1440 x 1080 pixels; pediatric retinal photograph (wide-field) — 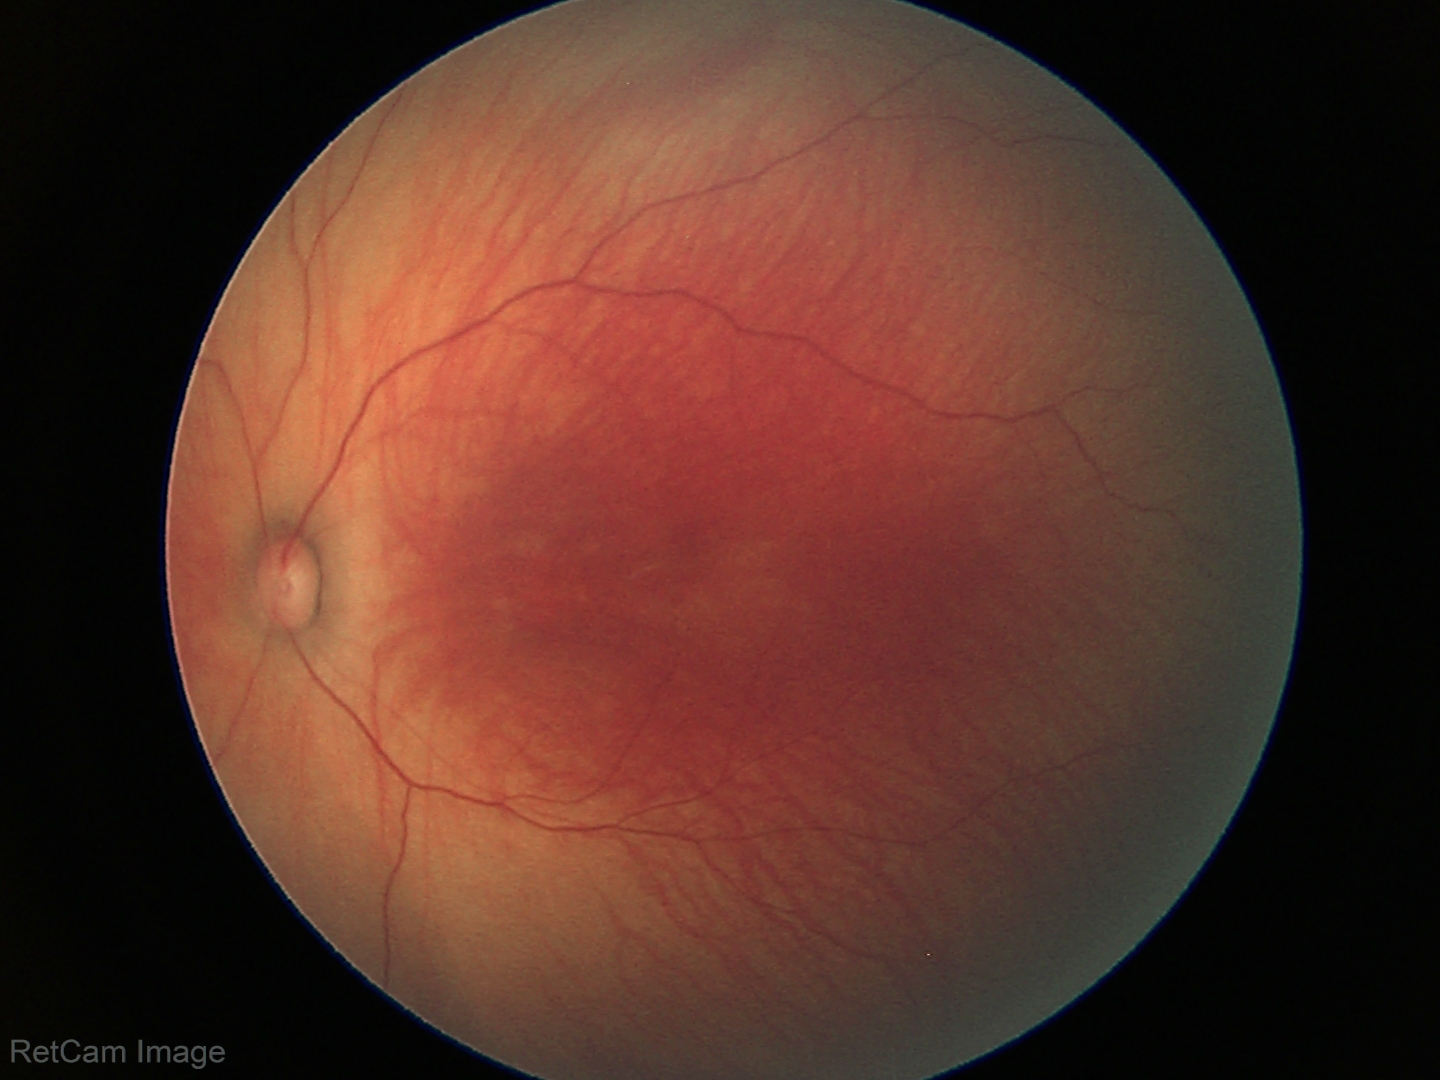

Normal screening examination.